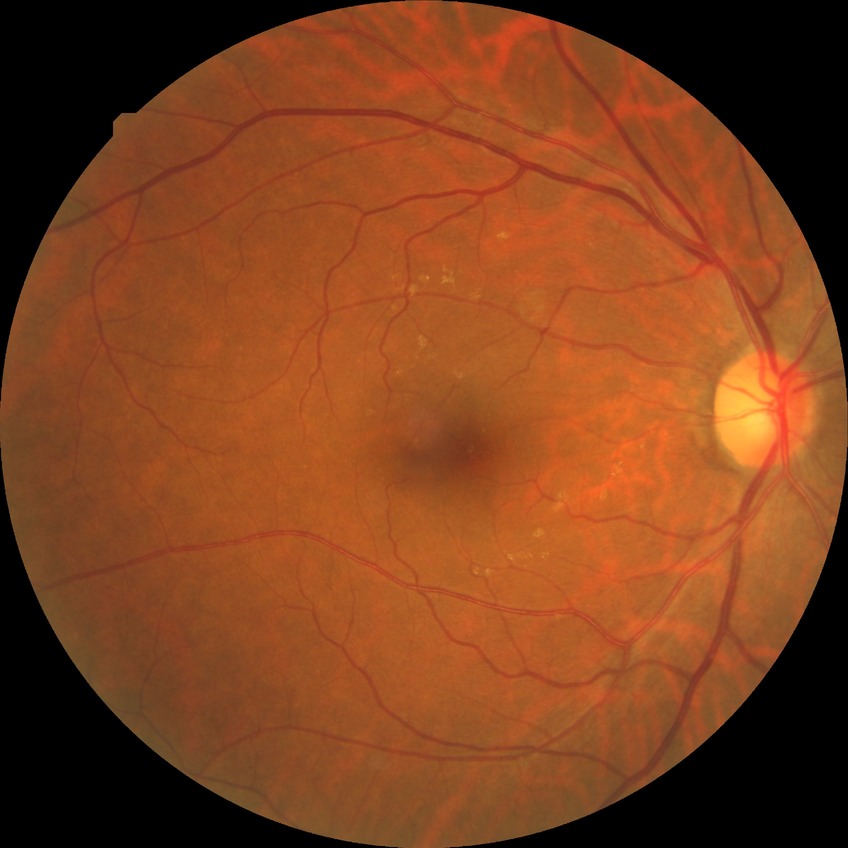
retinopathy stage: simple diabetic retinopathy; DR class: non-proliferative diabetic retinopathy.